848x848: 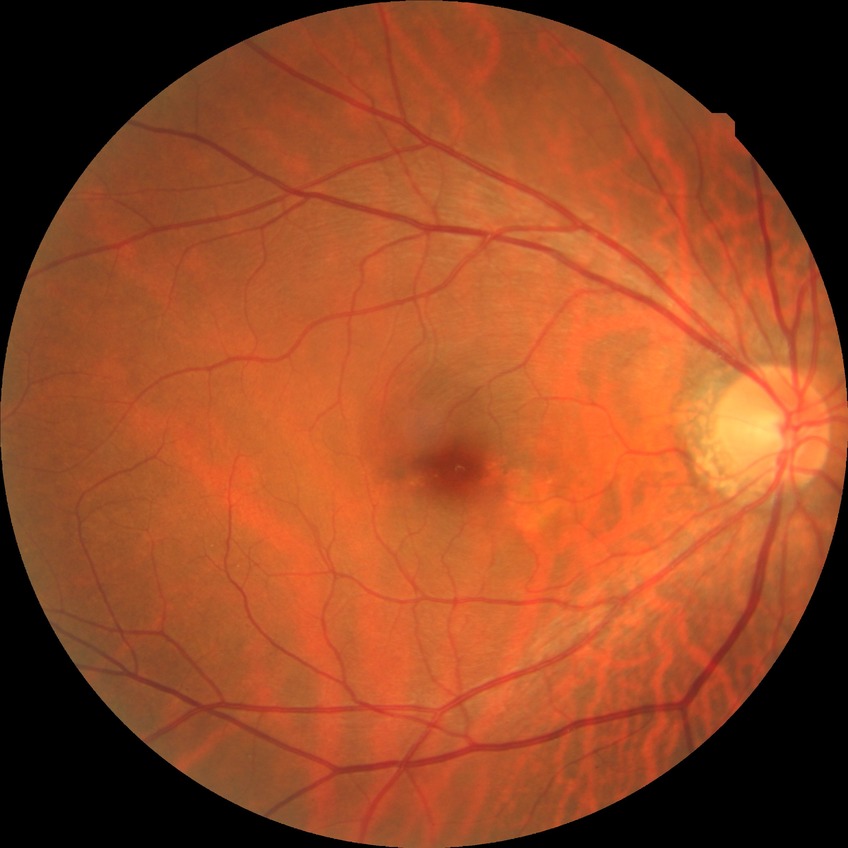 modified Davis classification: no diabetic retinopathy.